50° FOV, image size 1932x1932, captured after pupil dilation.
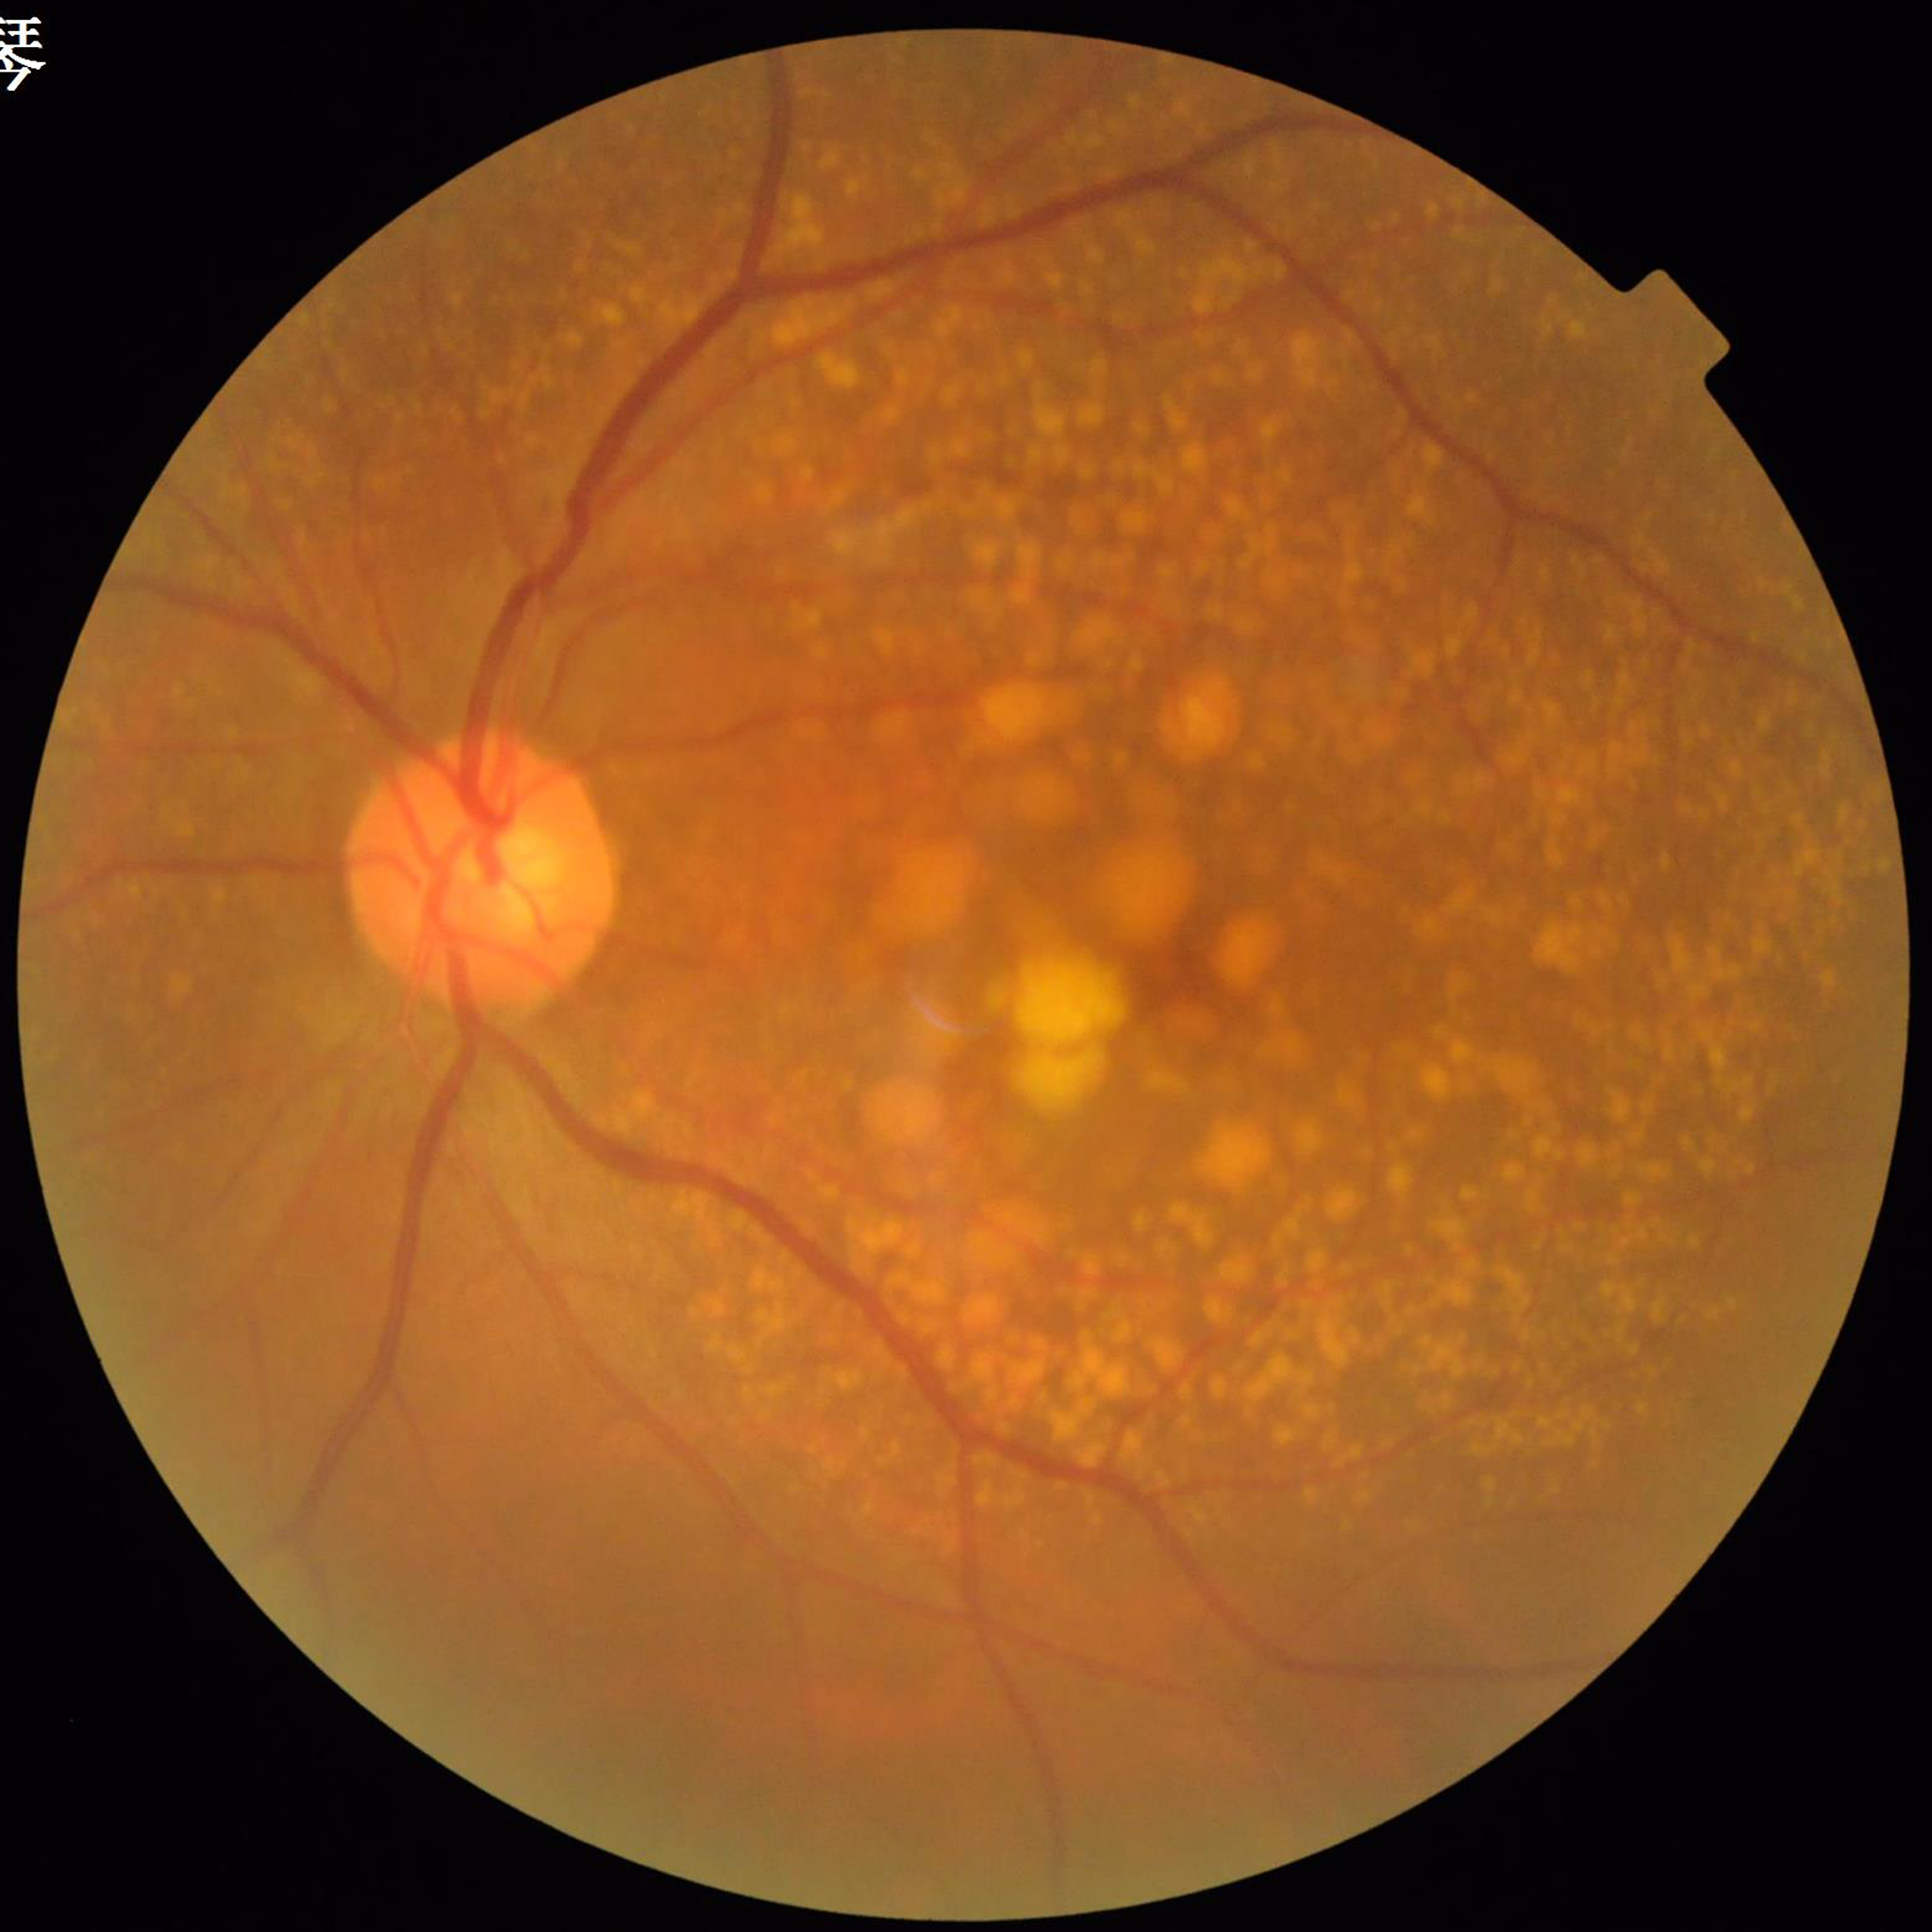

Image quality = no concerns identified | Impression = age-related macular degeneration.